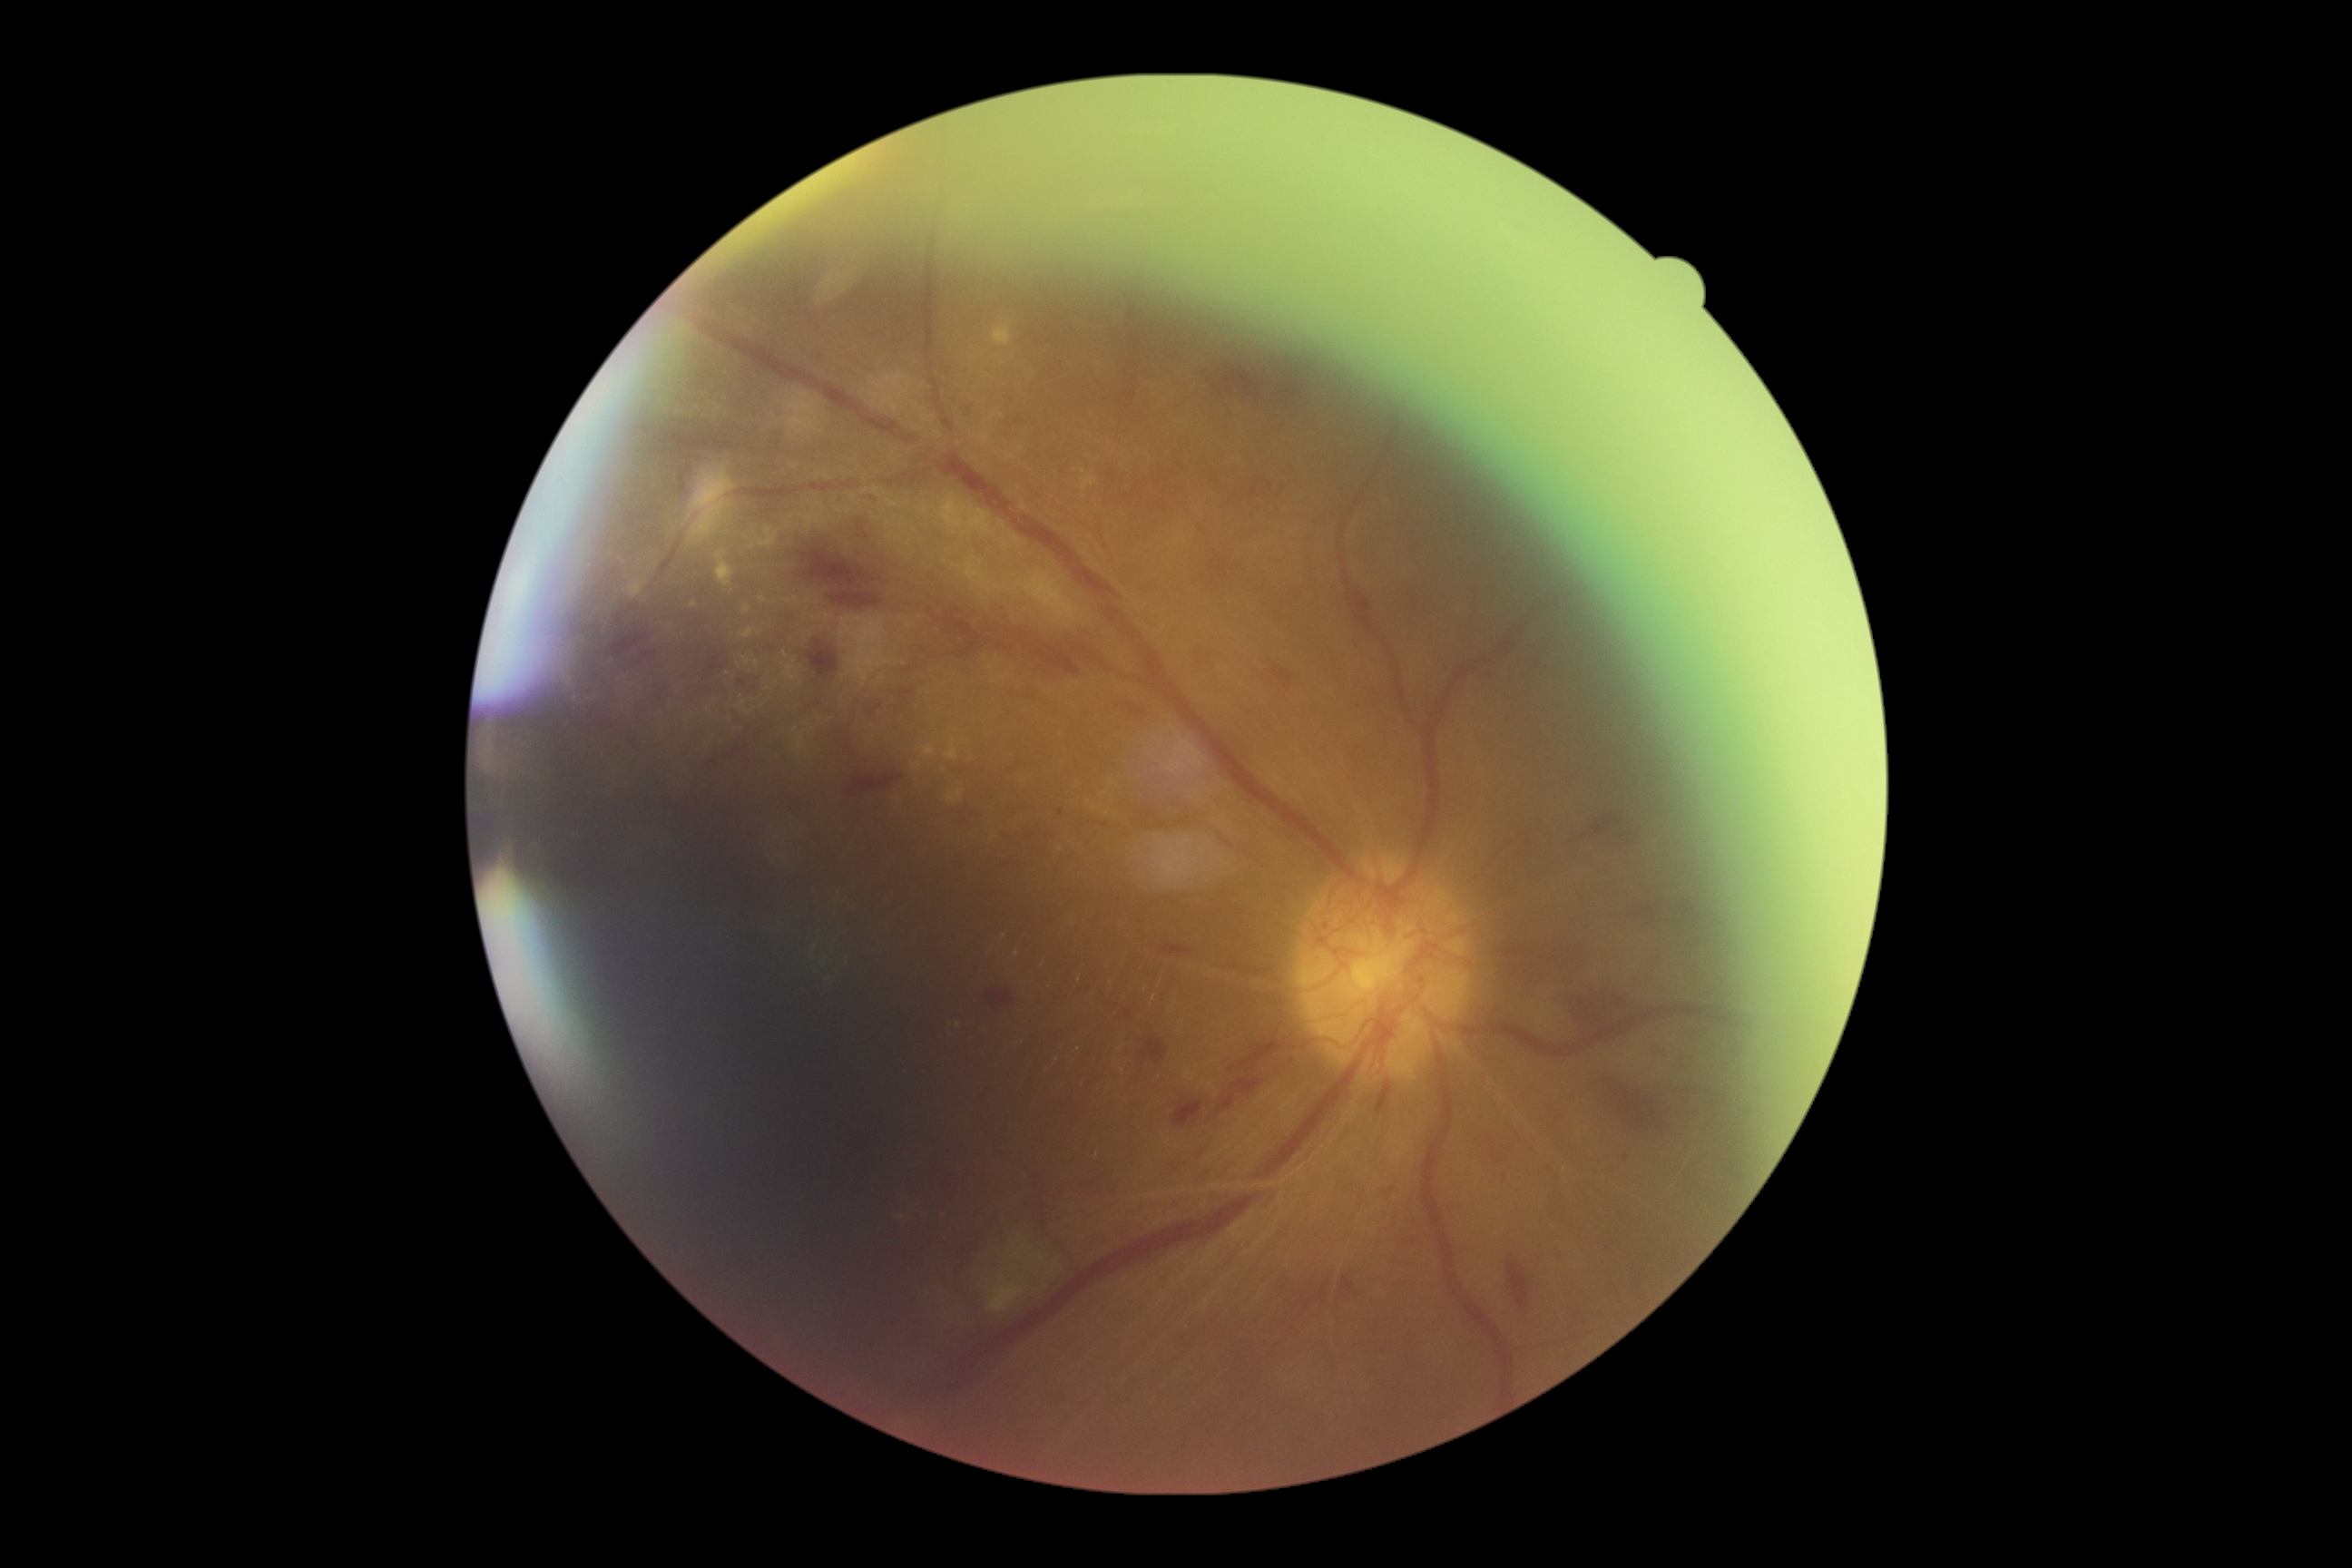

Annotations:
* diabetic retinopathy (DR): 4/4